Modified Davis classification.
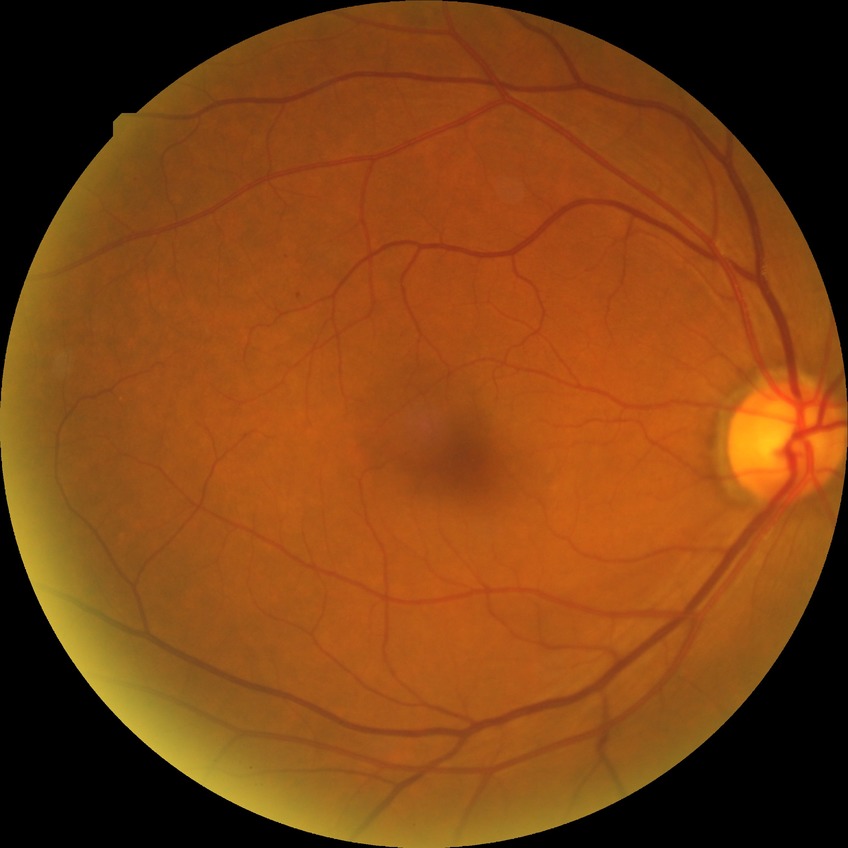
modified Davis grade=SDR, DR class=non-proliferative diabetic retinopathy.